Non-mydriatic fundus camera · fundus photo: 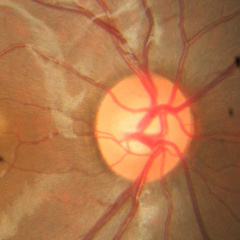

Optic disc appearance consistent with no glaucomatous changes.